1240x1240. Captured with the Phoenix ICON (100° field of view). Wide-field fundus photograph from neonatal ROP screening — 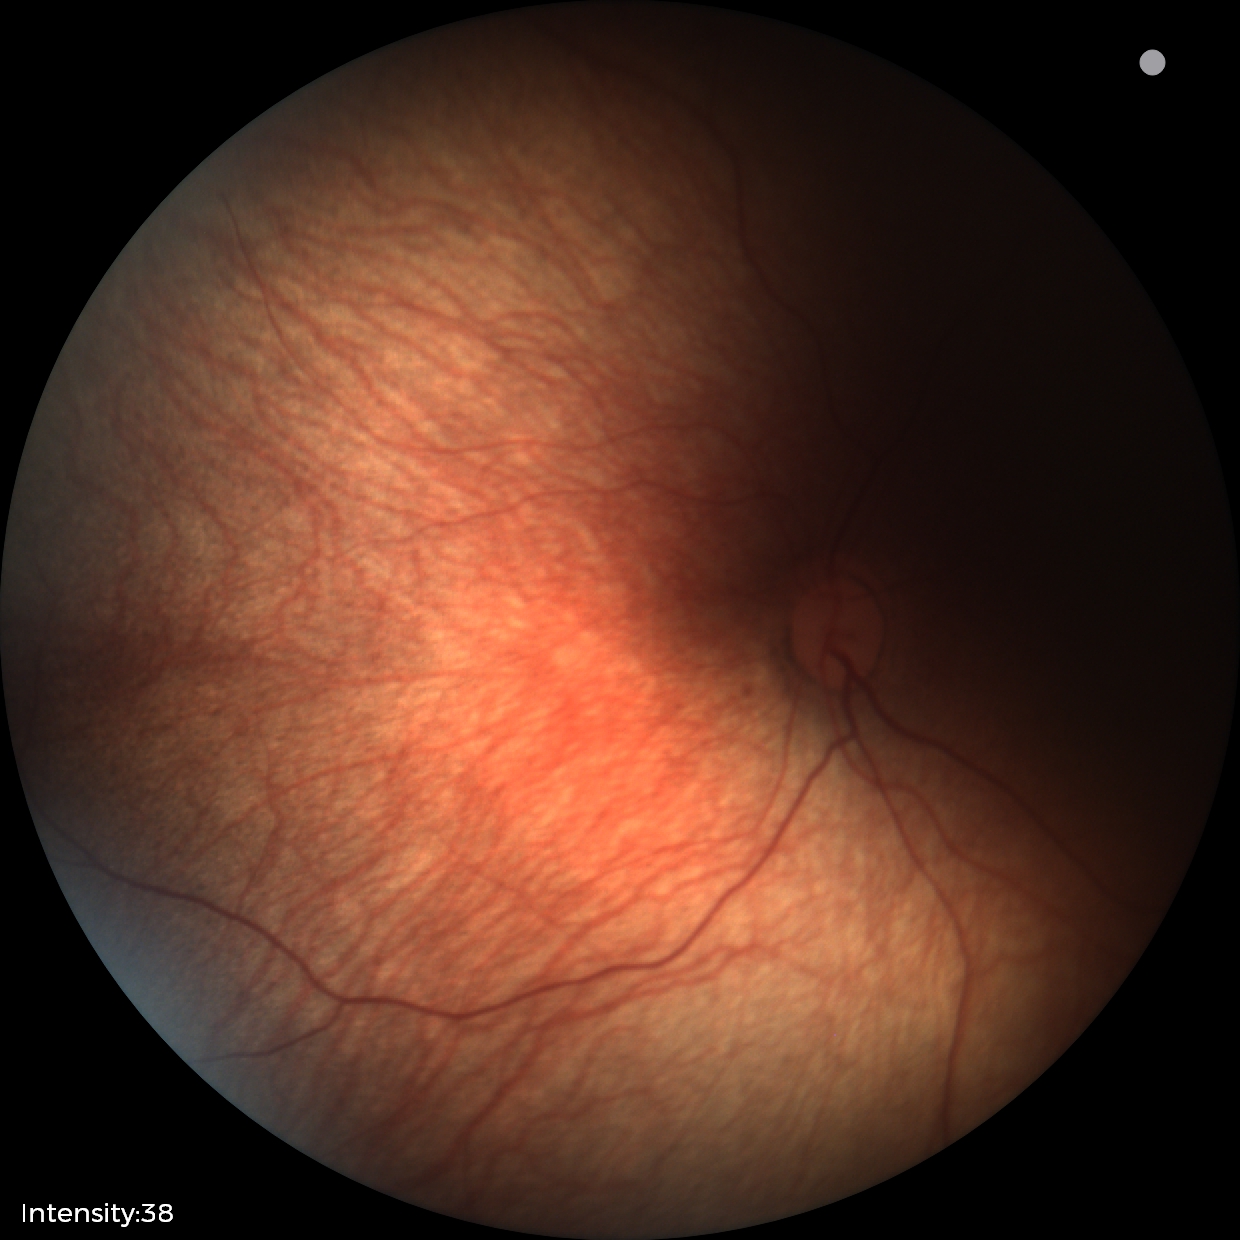 Assessment: no abnormalities.